Infant wide-field fundus photograph: 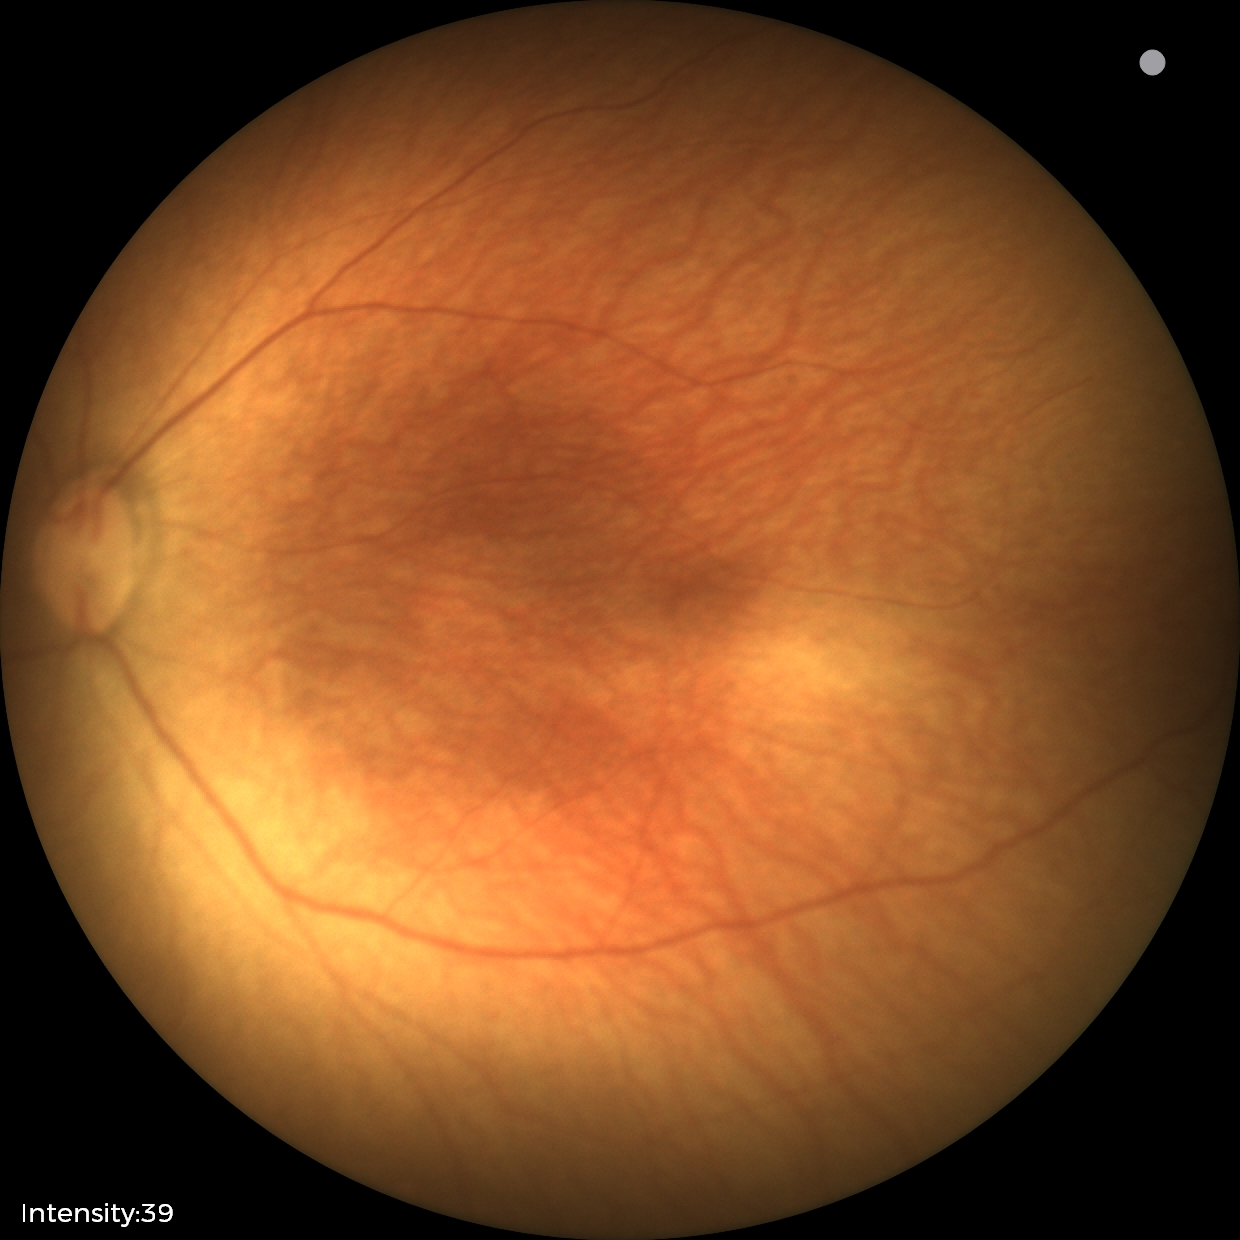 Screening examination with no abnormal retinal findings.